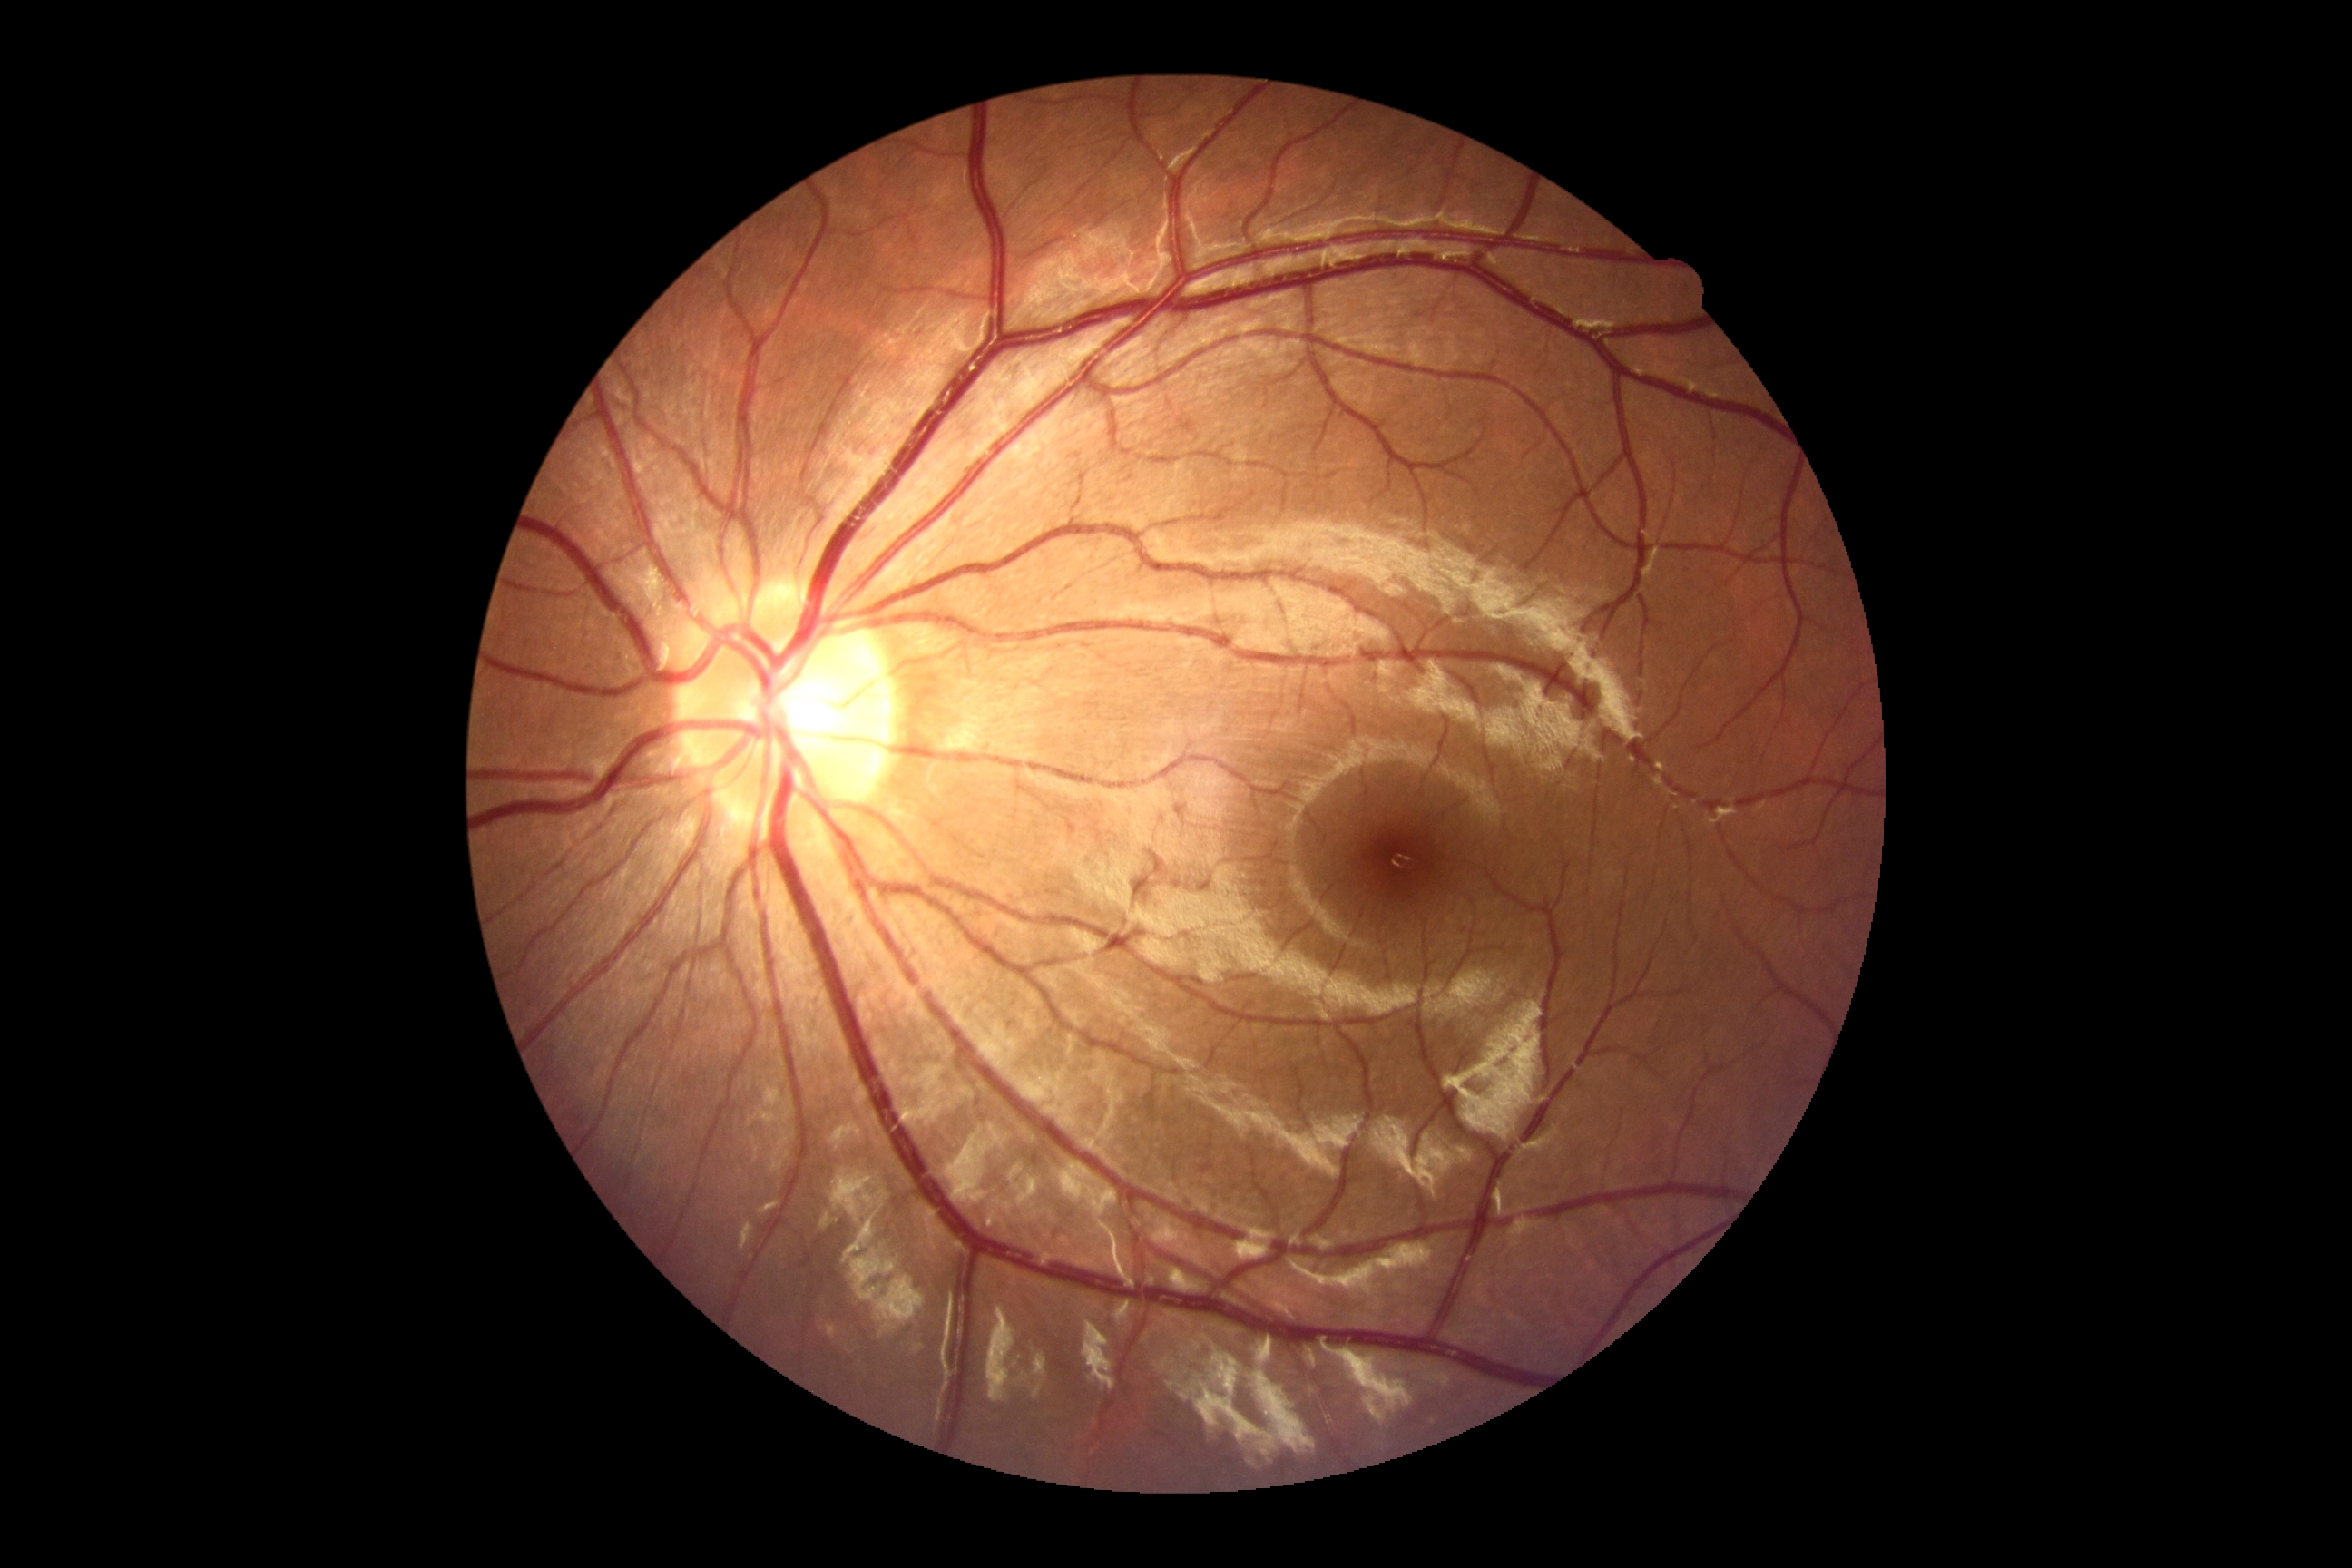
No DR findings.
DR: grade 0.